512x512px — 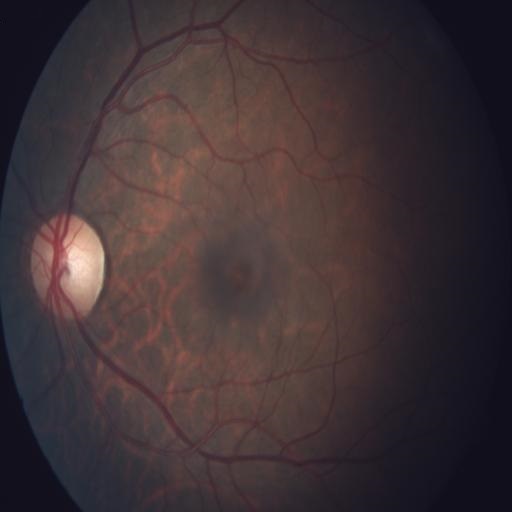 Impression: chorioretinitis.